Infant wide-field fundus photograph
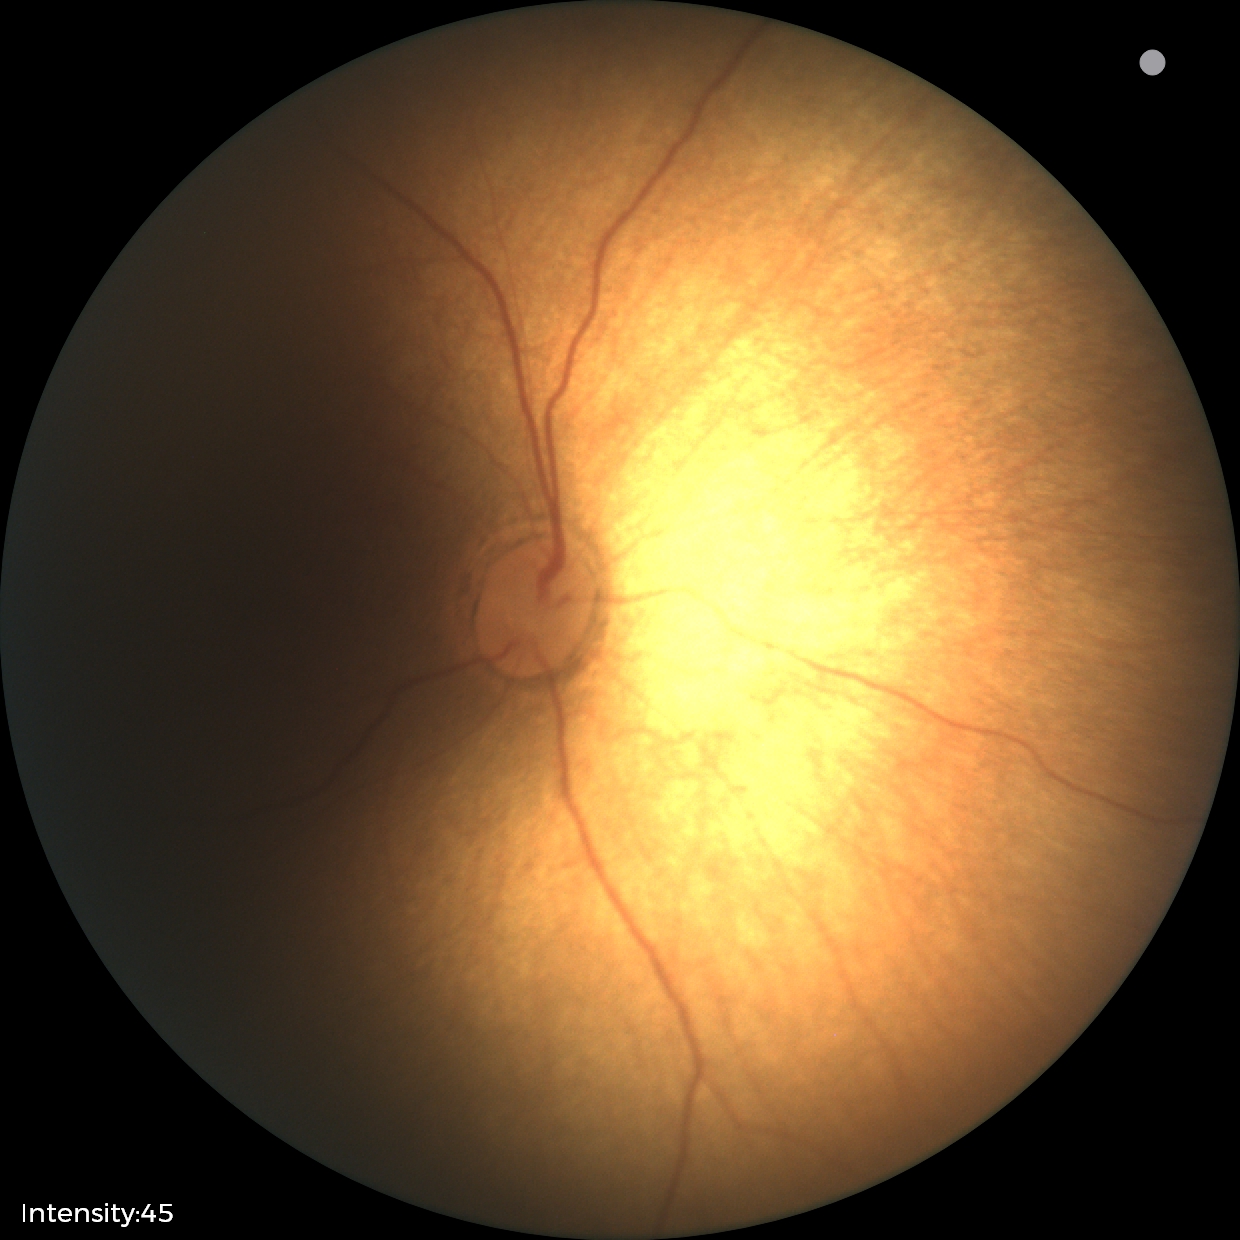 No retinal pathology identified on screening.